Acquired with a NIDEK AFC-230
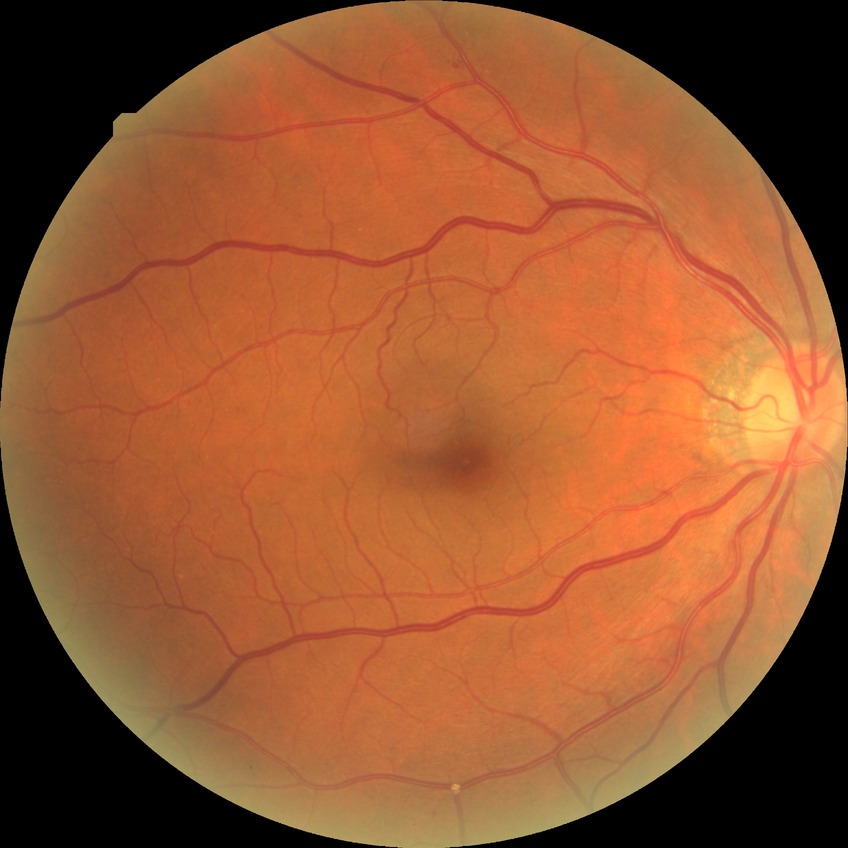 retinopathy stage=simple diabetic retinopathy.